Pediatric retinal photograph (wide-field); captured with the Clarity RetCam 3 (130° field of view); 640 x 480 pixels:
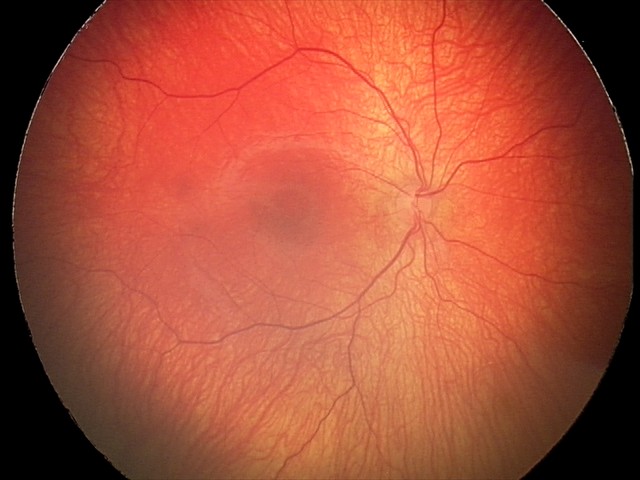
Impression: status post retinopathy of prematurity — retinal appearance after treated retinopathy of prematurity | plus disease: absent.